Wide-field fundus photograph from neonatal ROP screening. 1240 x 1240 pixels.
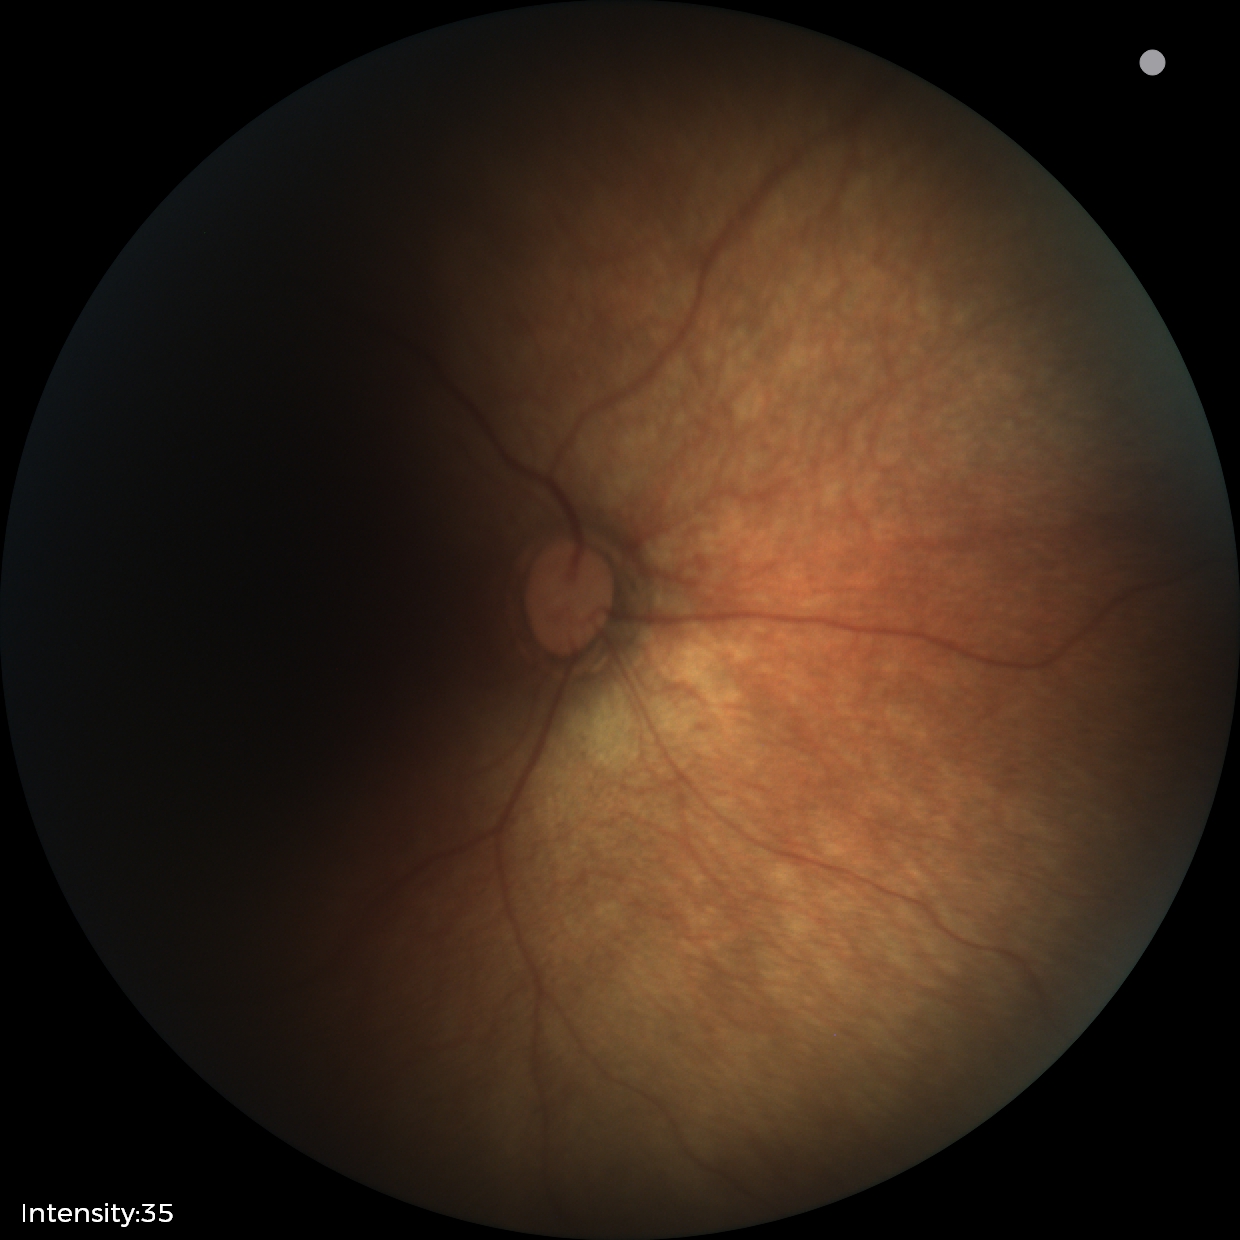
Diagnosis = normal